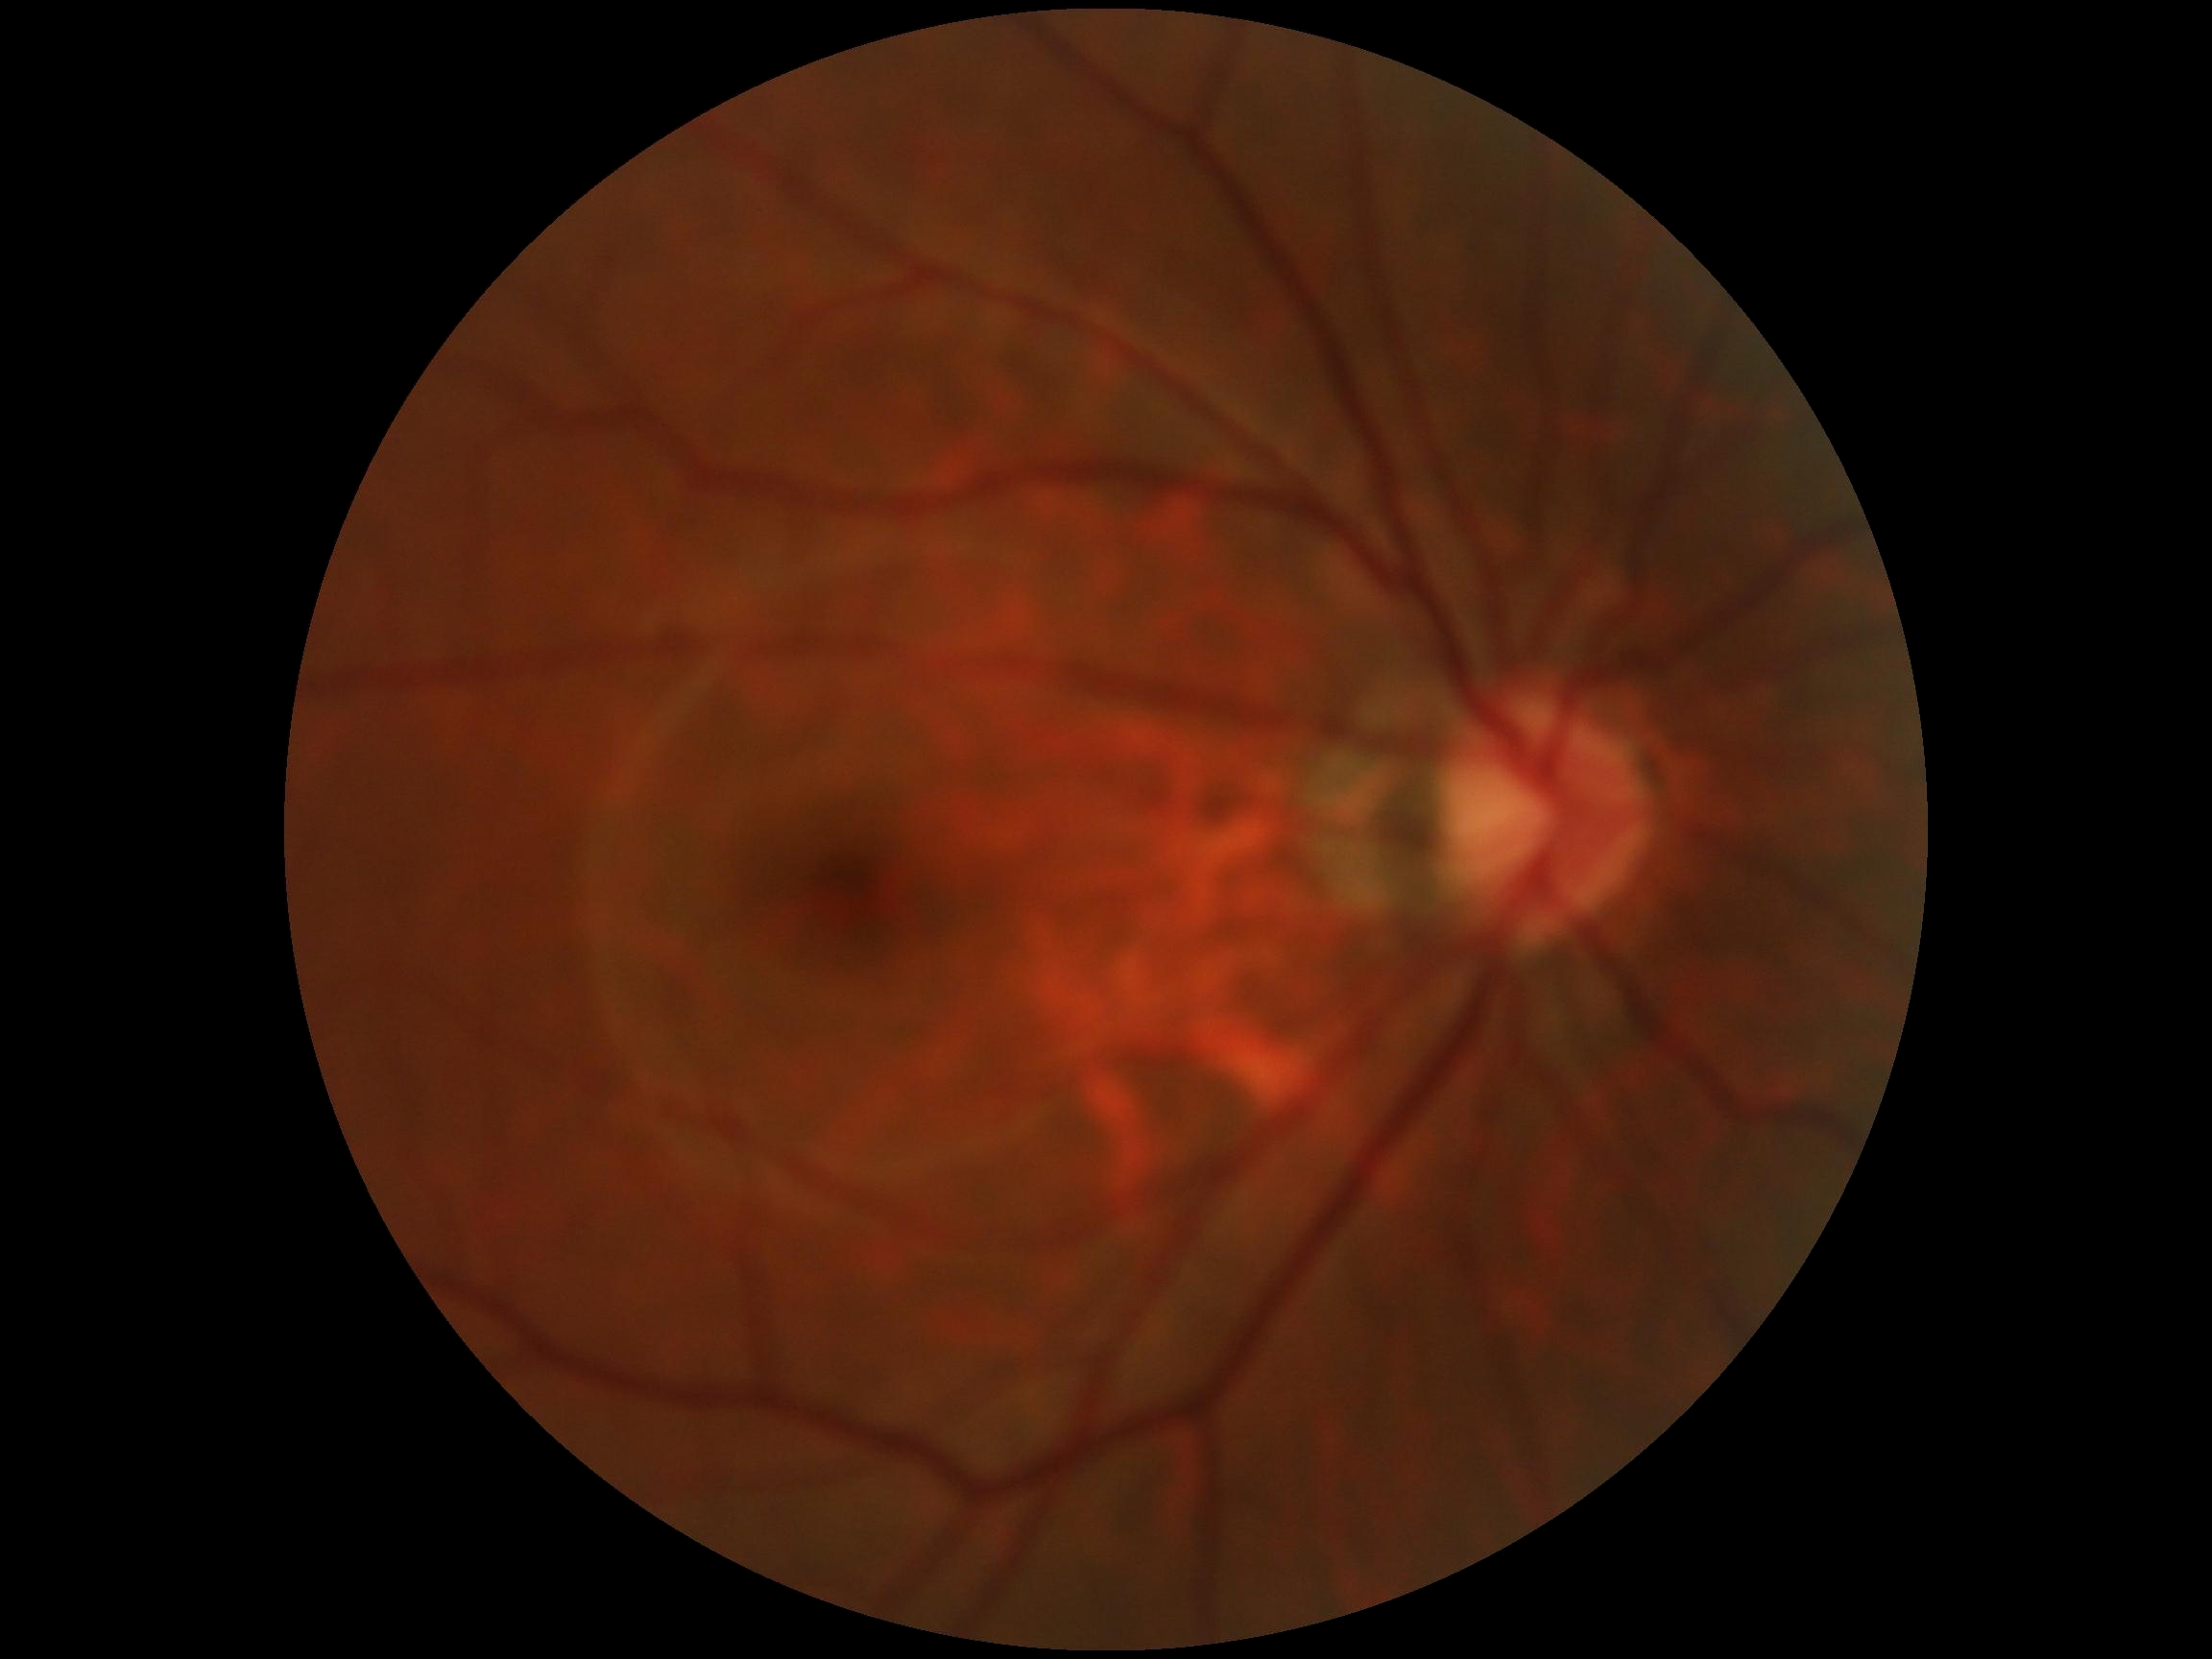

DR severity = no apparent retinopathy (grade 0) | DR impression = no DR findings.